45-degree field of view: 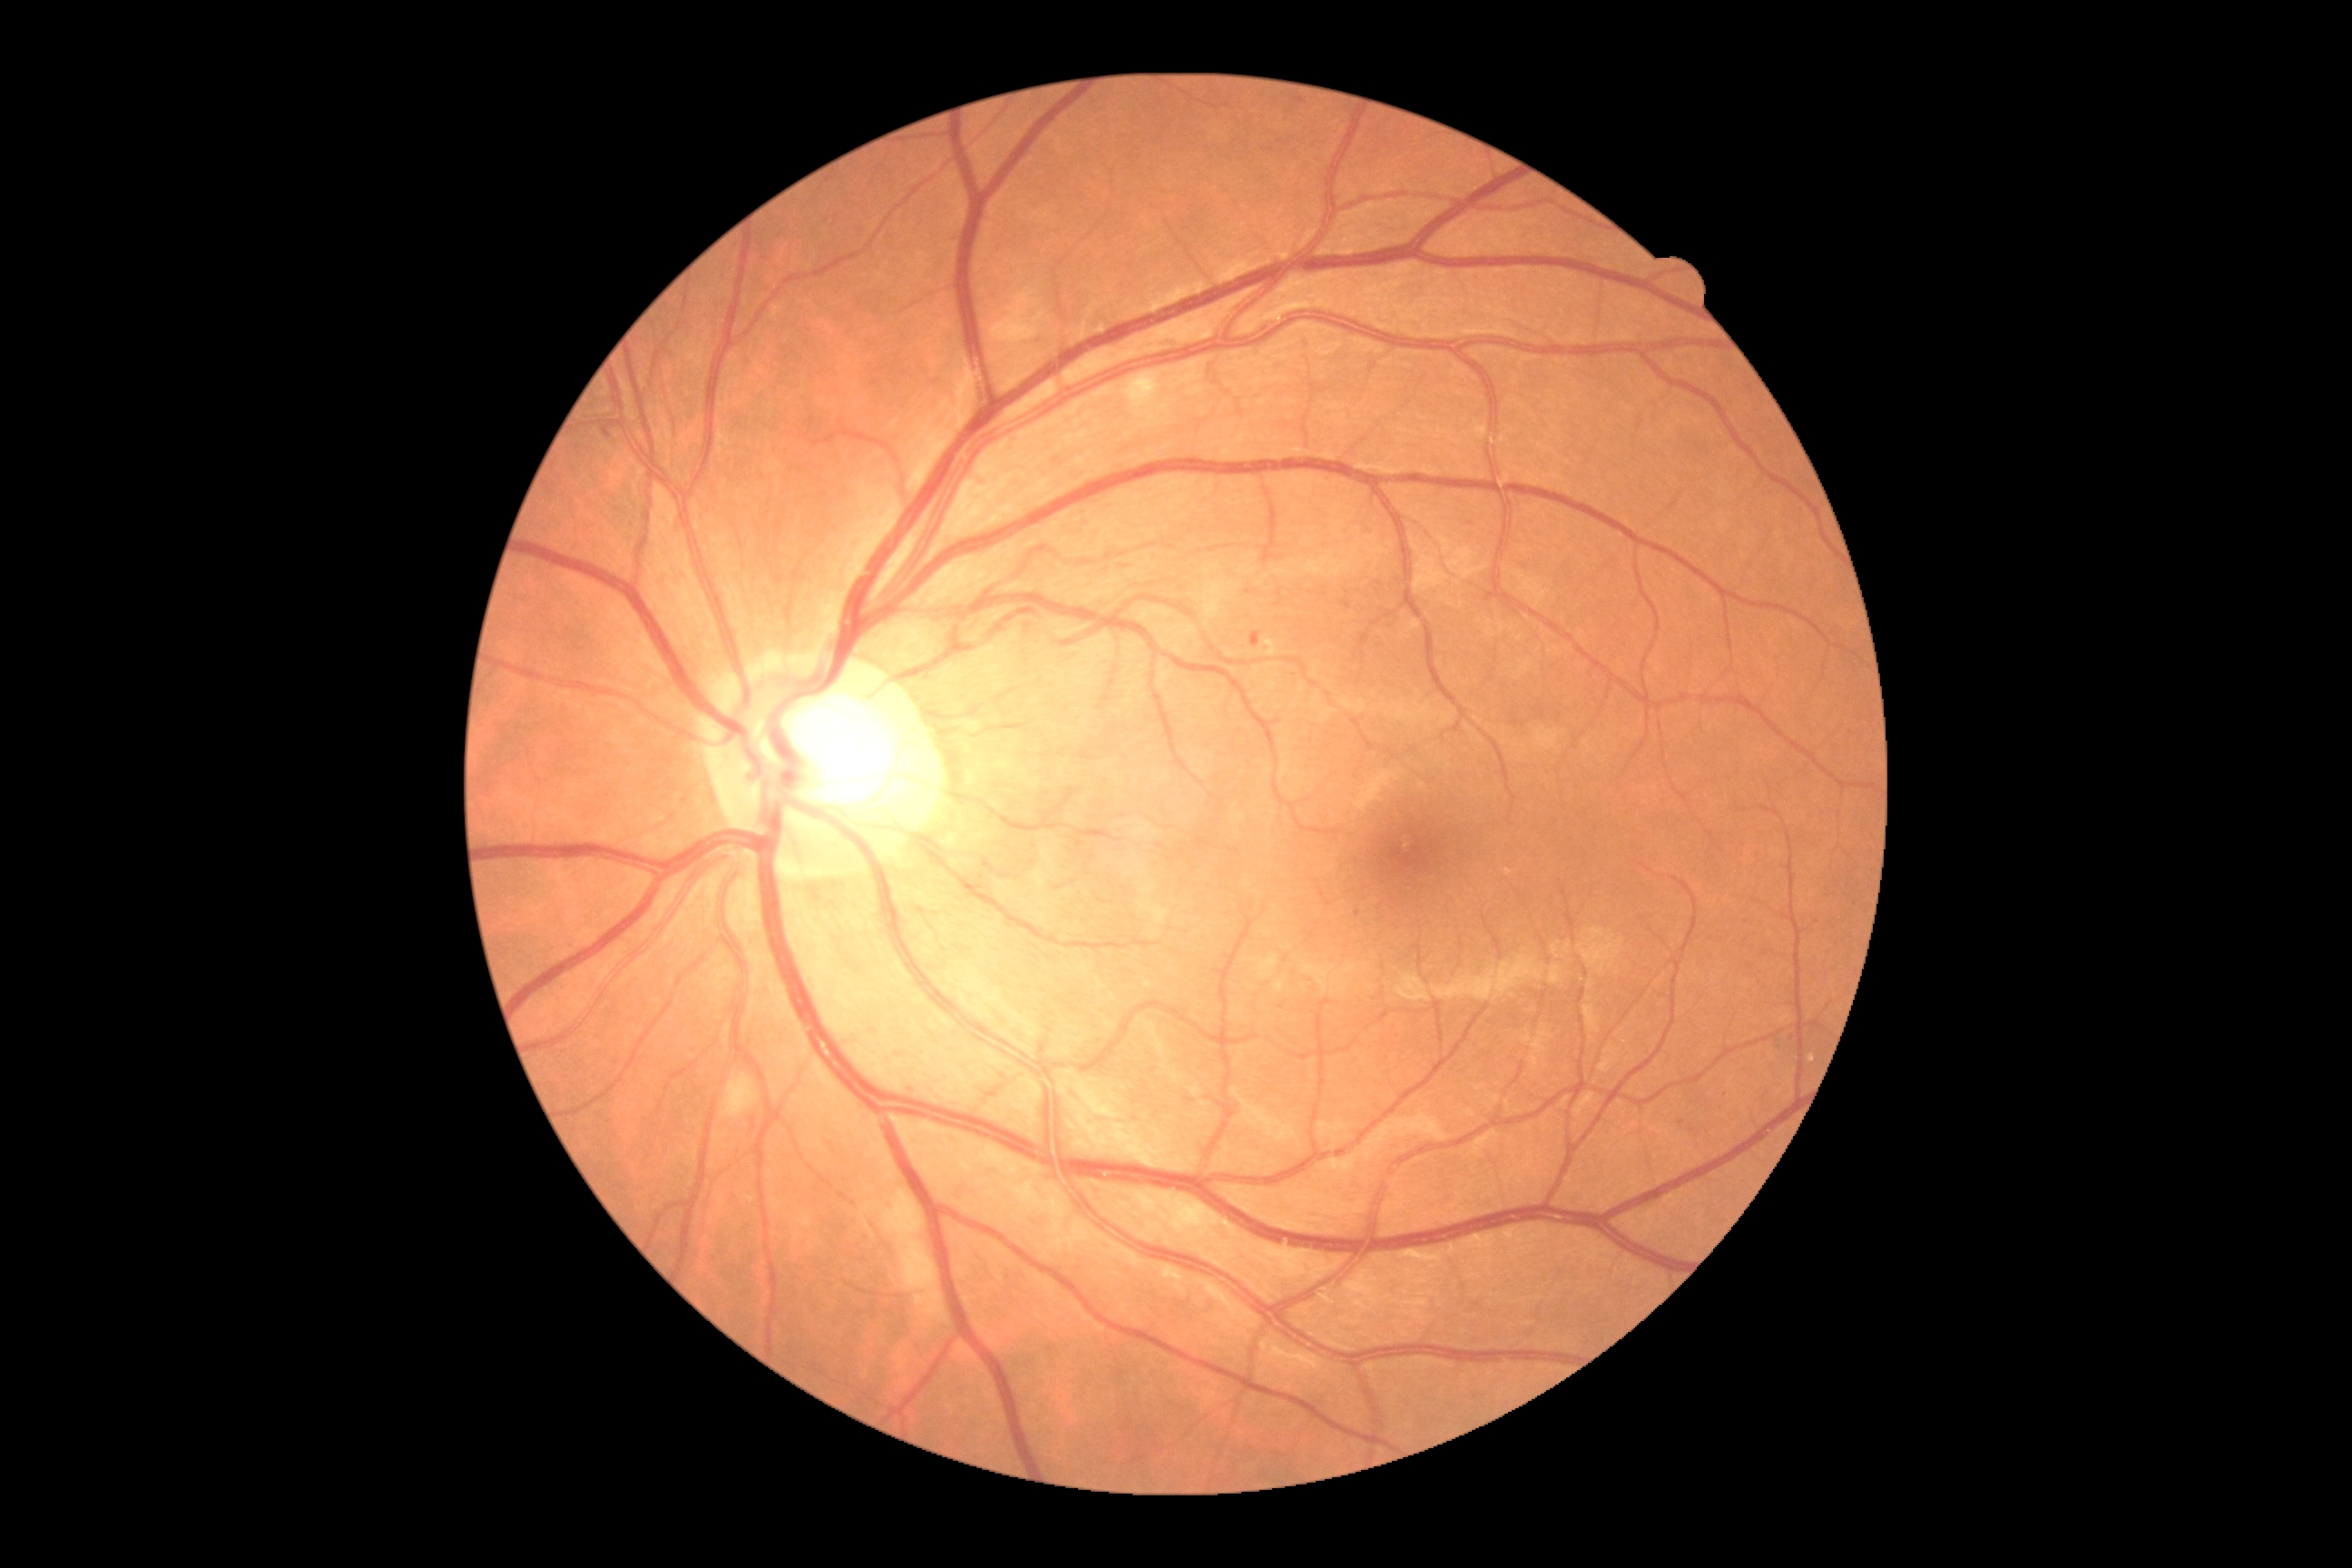
DR is grade 2 (moderate NPDR). The retinopathy is classified as non-proliferative diabetic retinopathy.